Wide-field fundus photograph from neonatal ROP screening · acquired on the Phoenix ICON
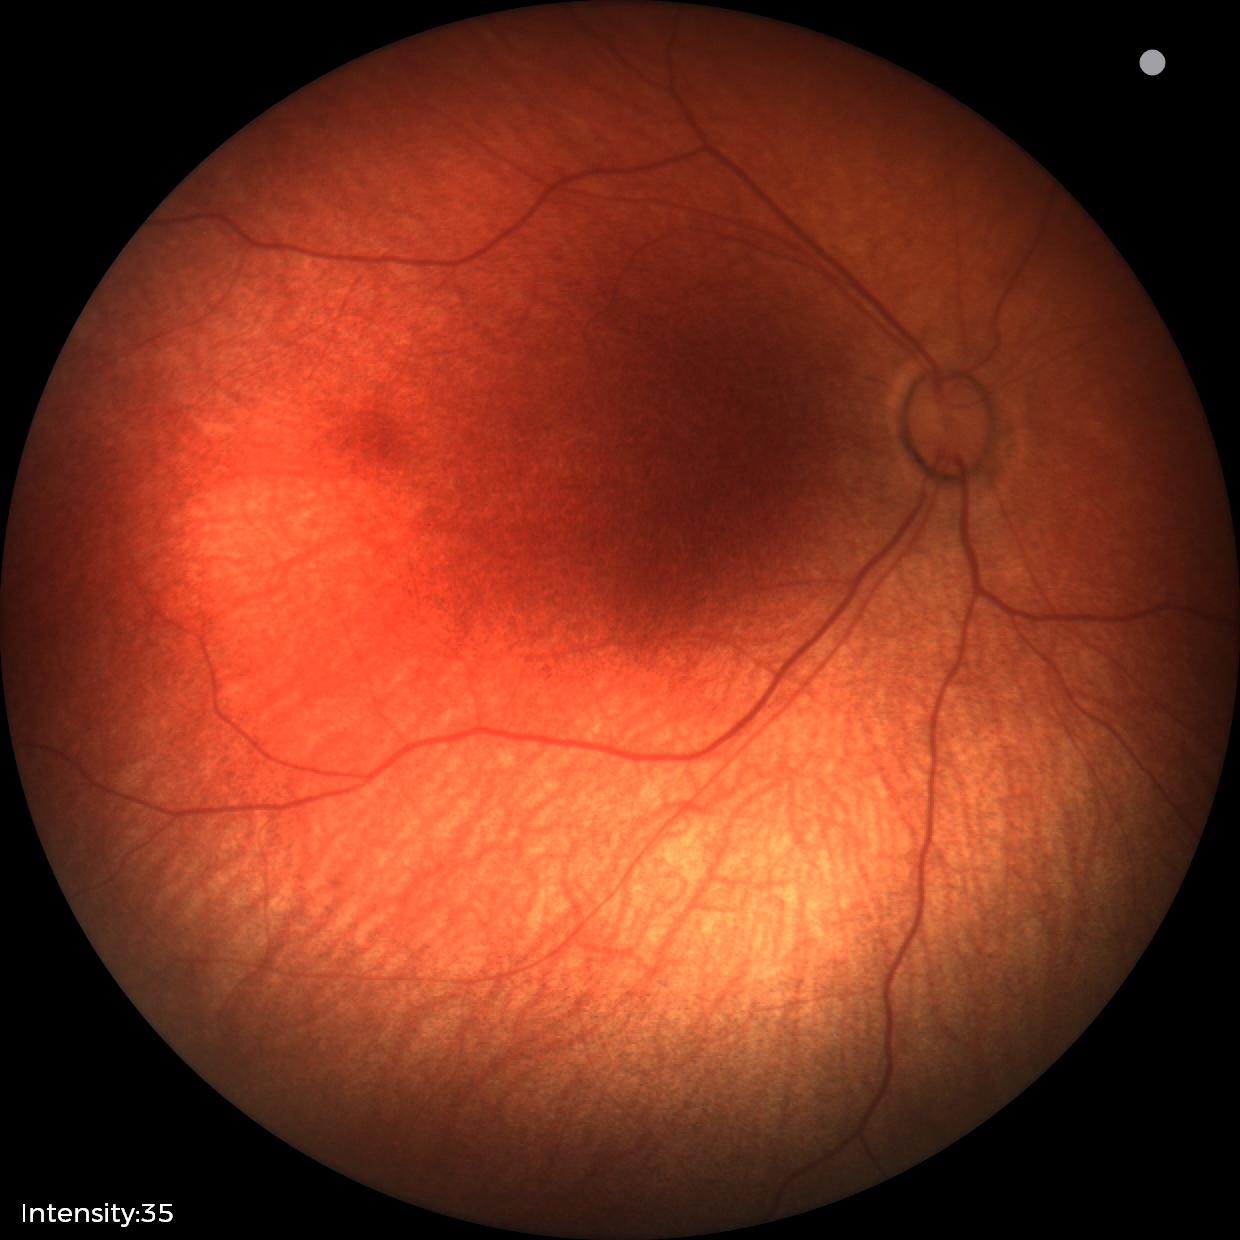 Screening examination diagnosed as physiological.